Fundus photo; 50° field of view; 1924 x 1556 pixels:
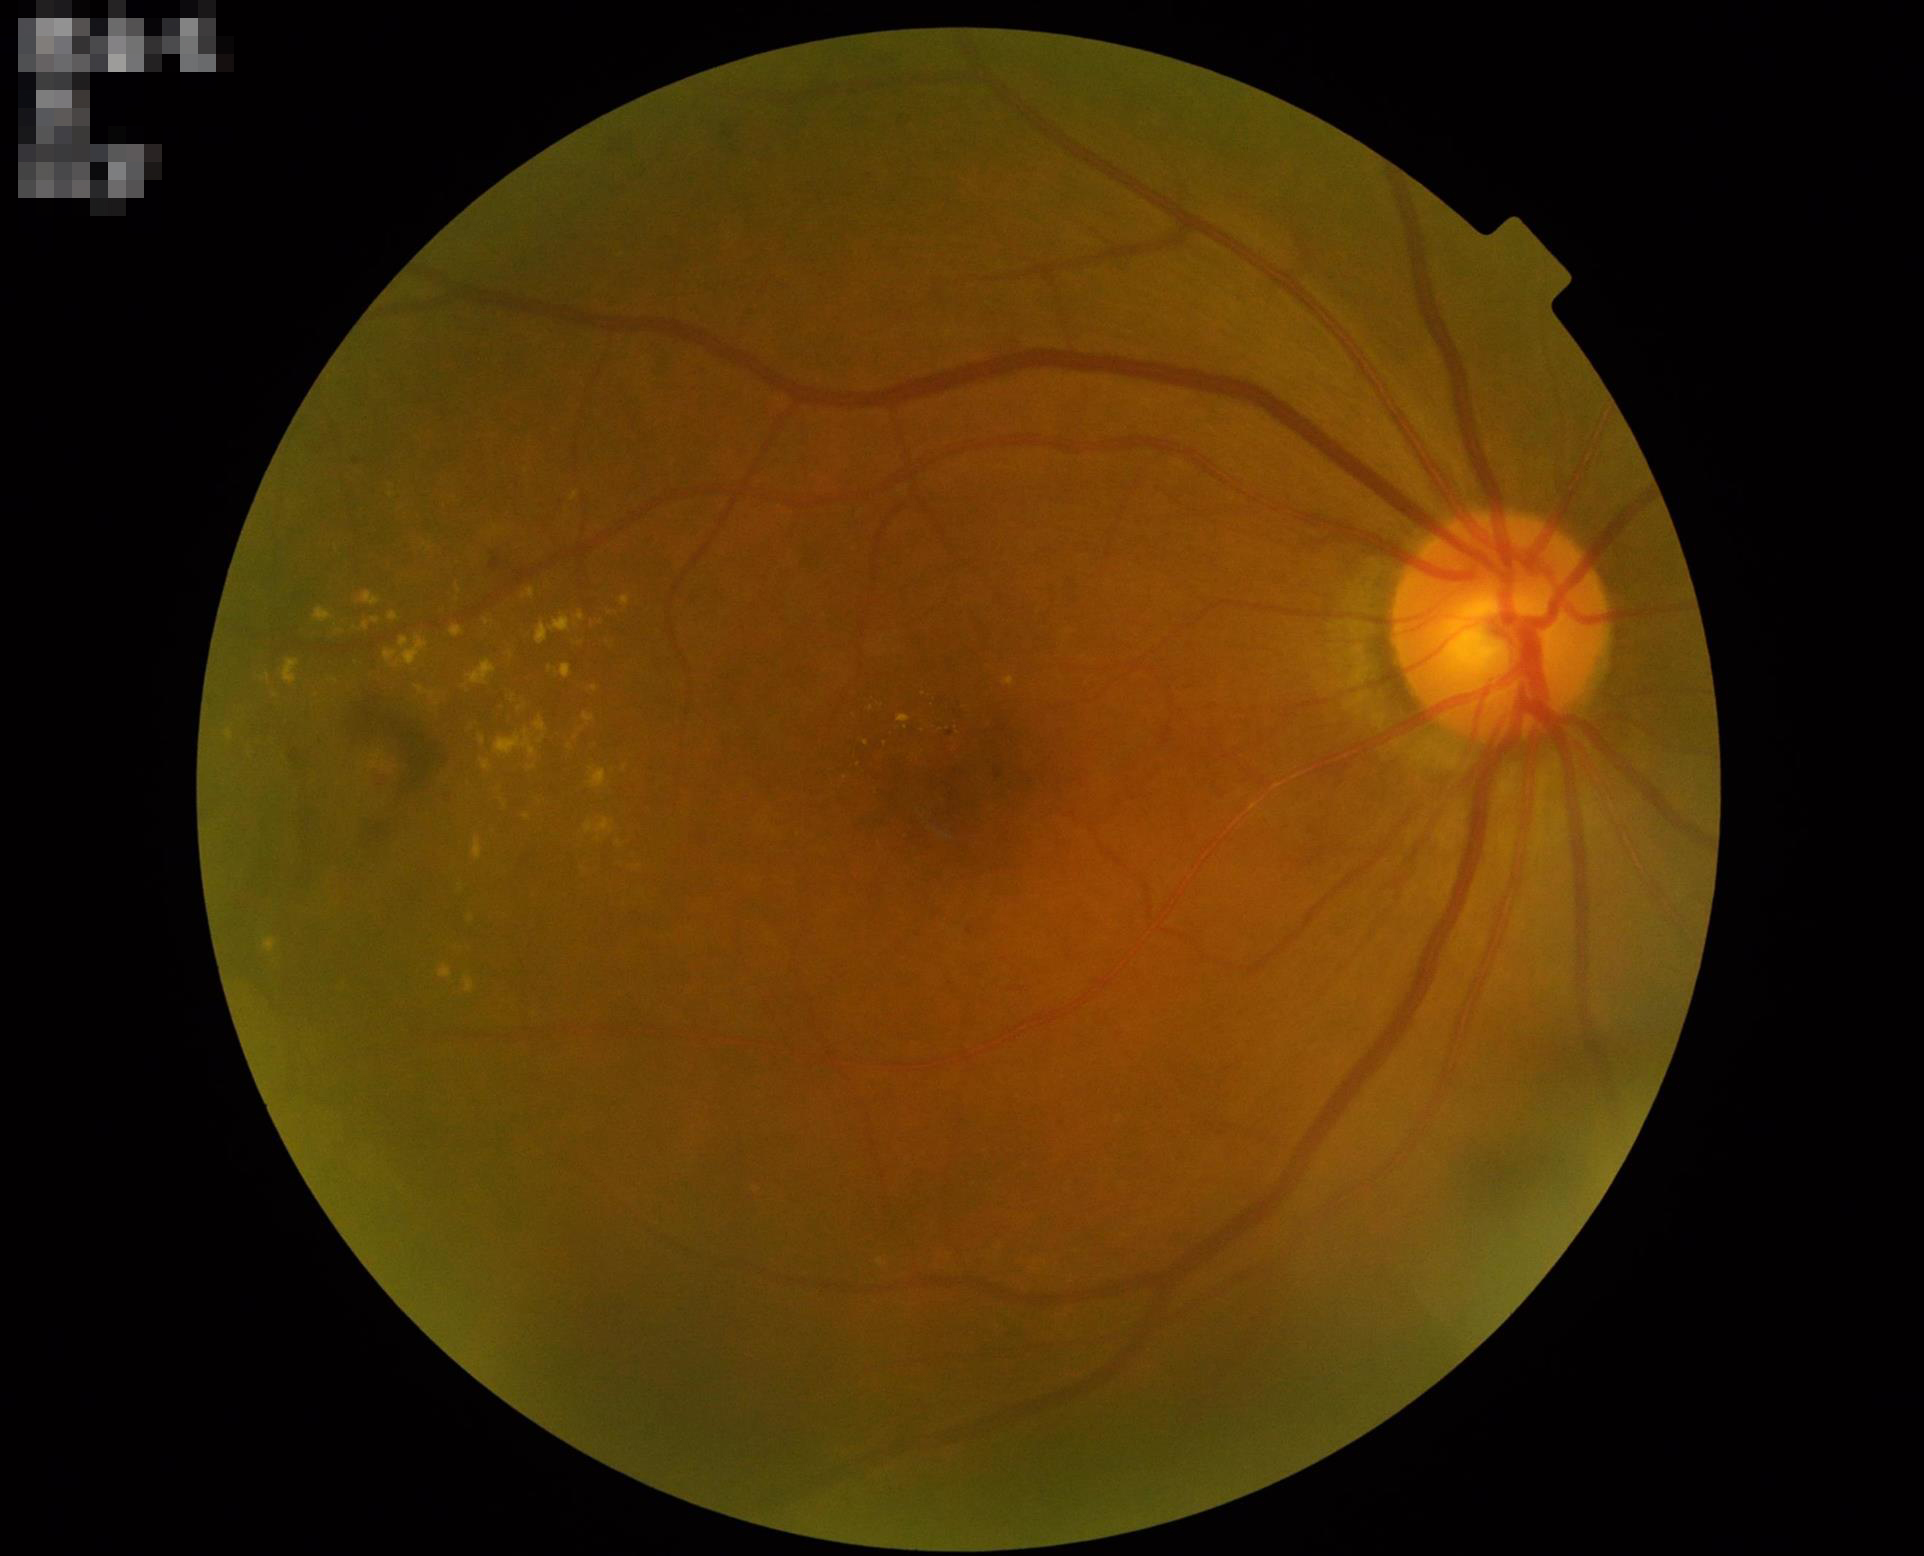
Overall quality is good and the image is gradable.
Optic disc, vessels, and background are in focus.
Poor illumination with uneven exposure.
Adequate contrast for distinguishing structures.